Pediatric retinal photograph (wide-field).
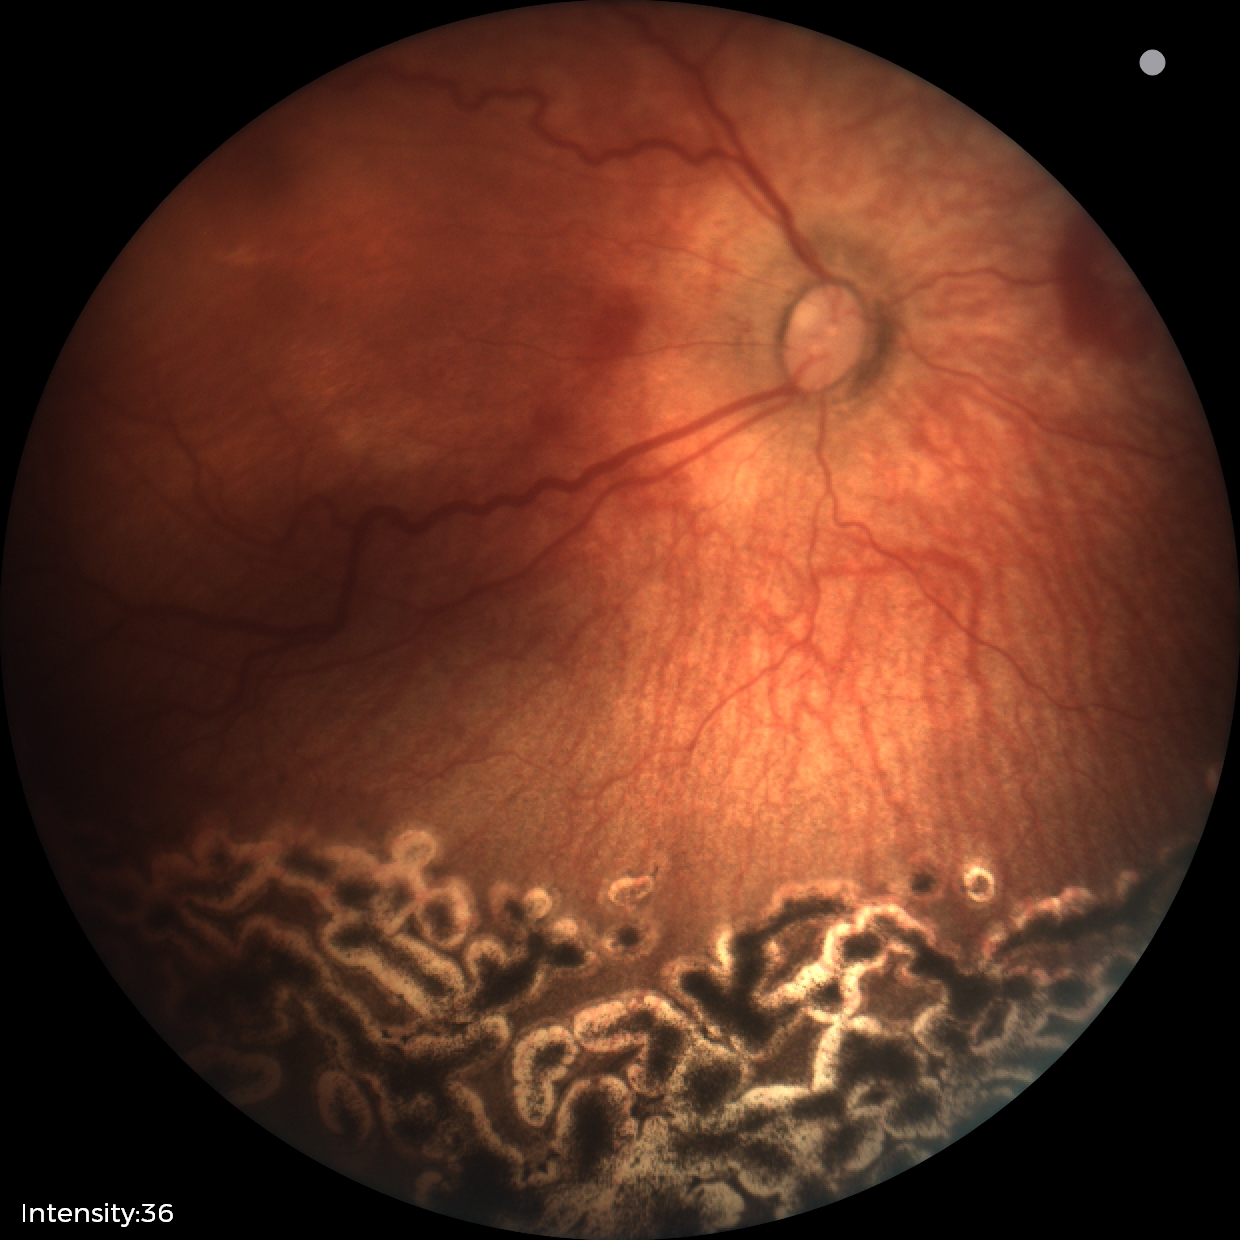
Diagnosis from this screening exam: status post ROP. Without plus disease.